2228 x 1652 pixels. Posterior pole view: 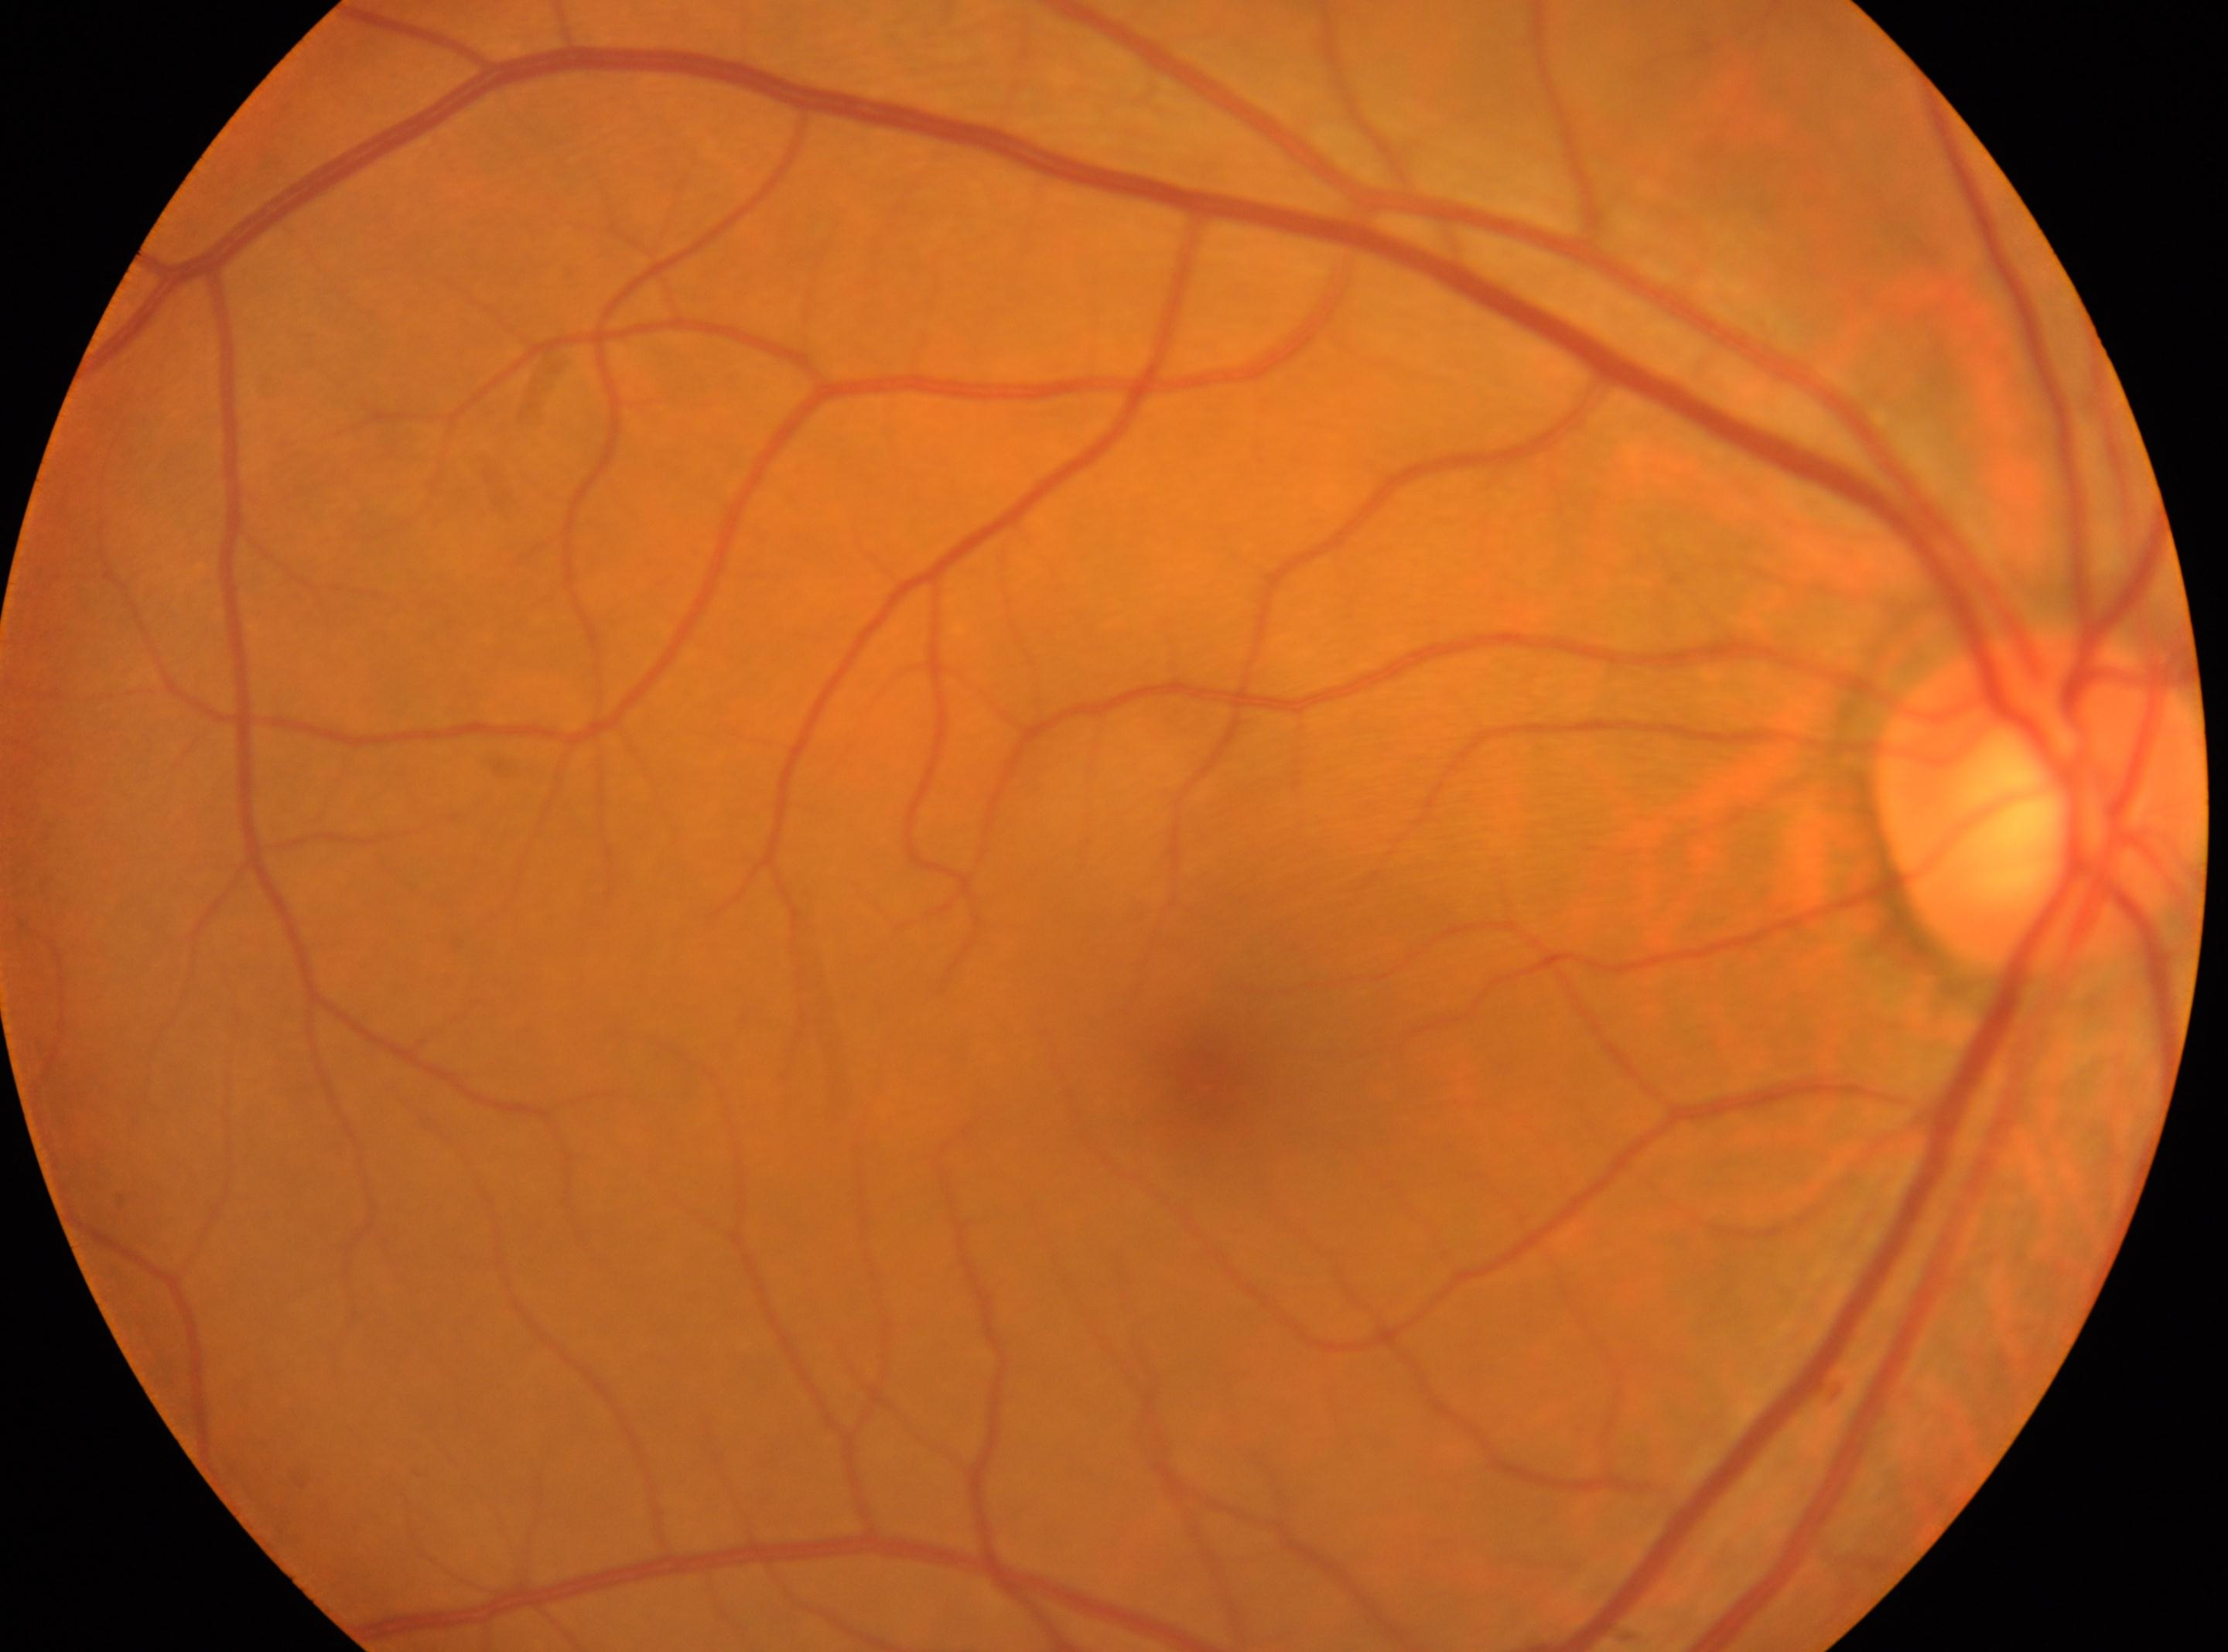 Q: What is the DR grade?
A: no apparent diabetic retinopathy (grade 0)
Q: Where is the optic disc?
A: 2039px, 798px
Q: Locate the fovea.
A: 1211px, 1073px
Q: Right or left eye?
A: the right eye